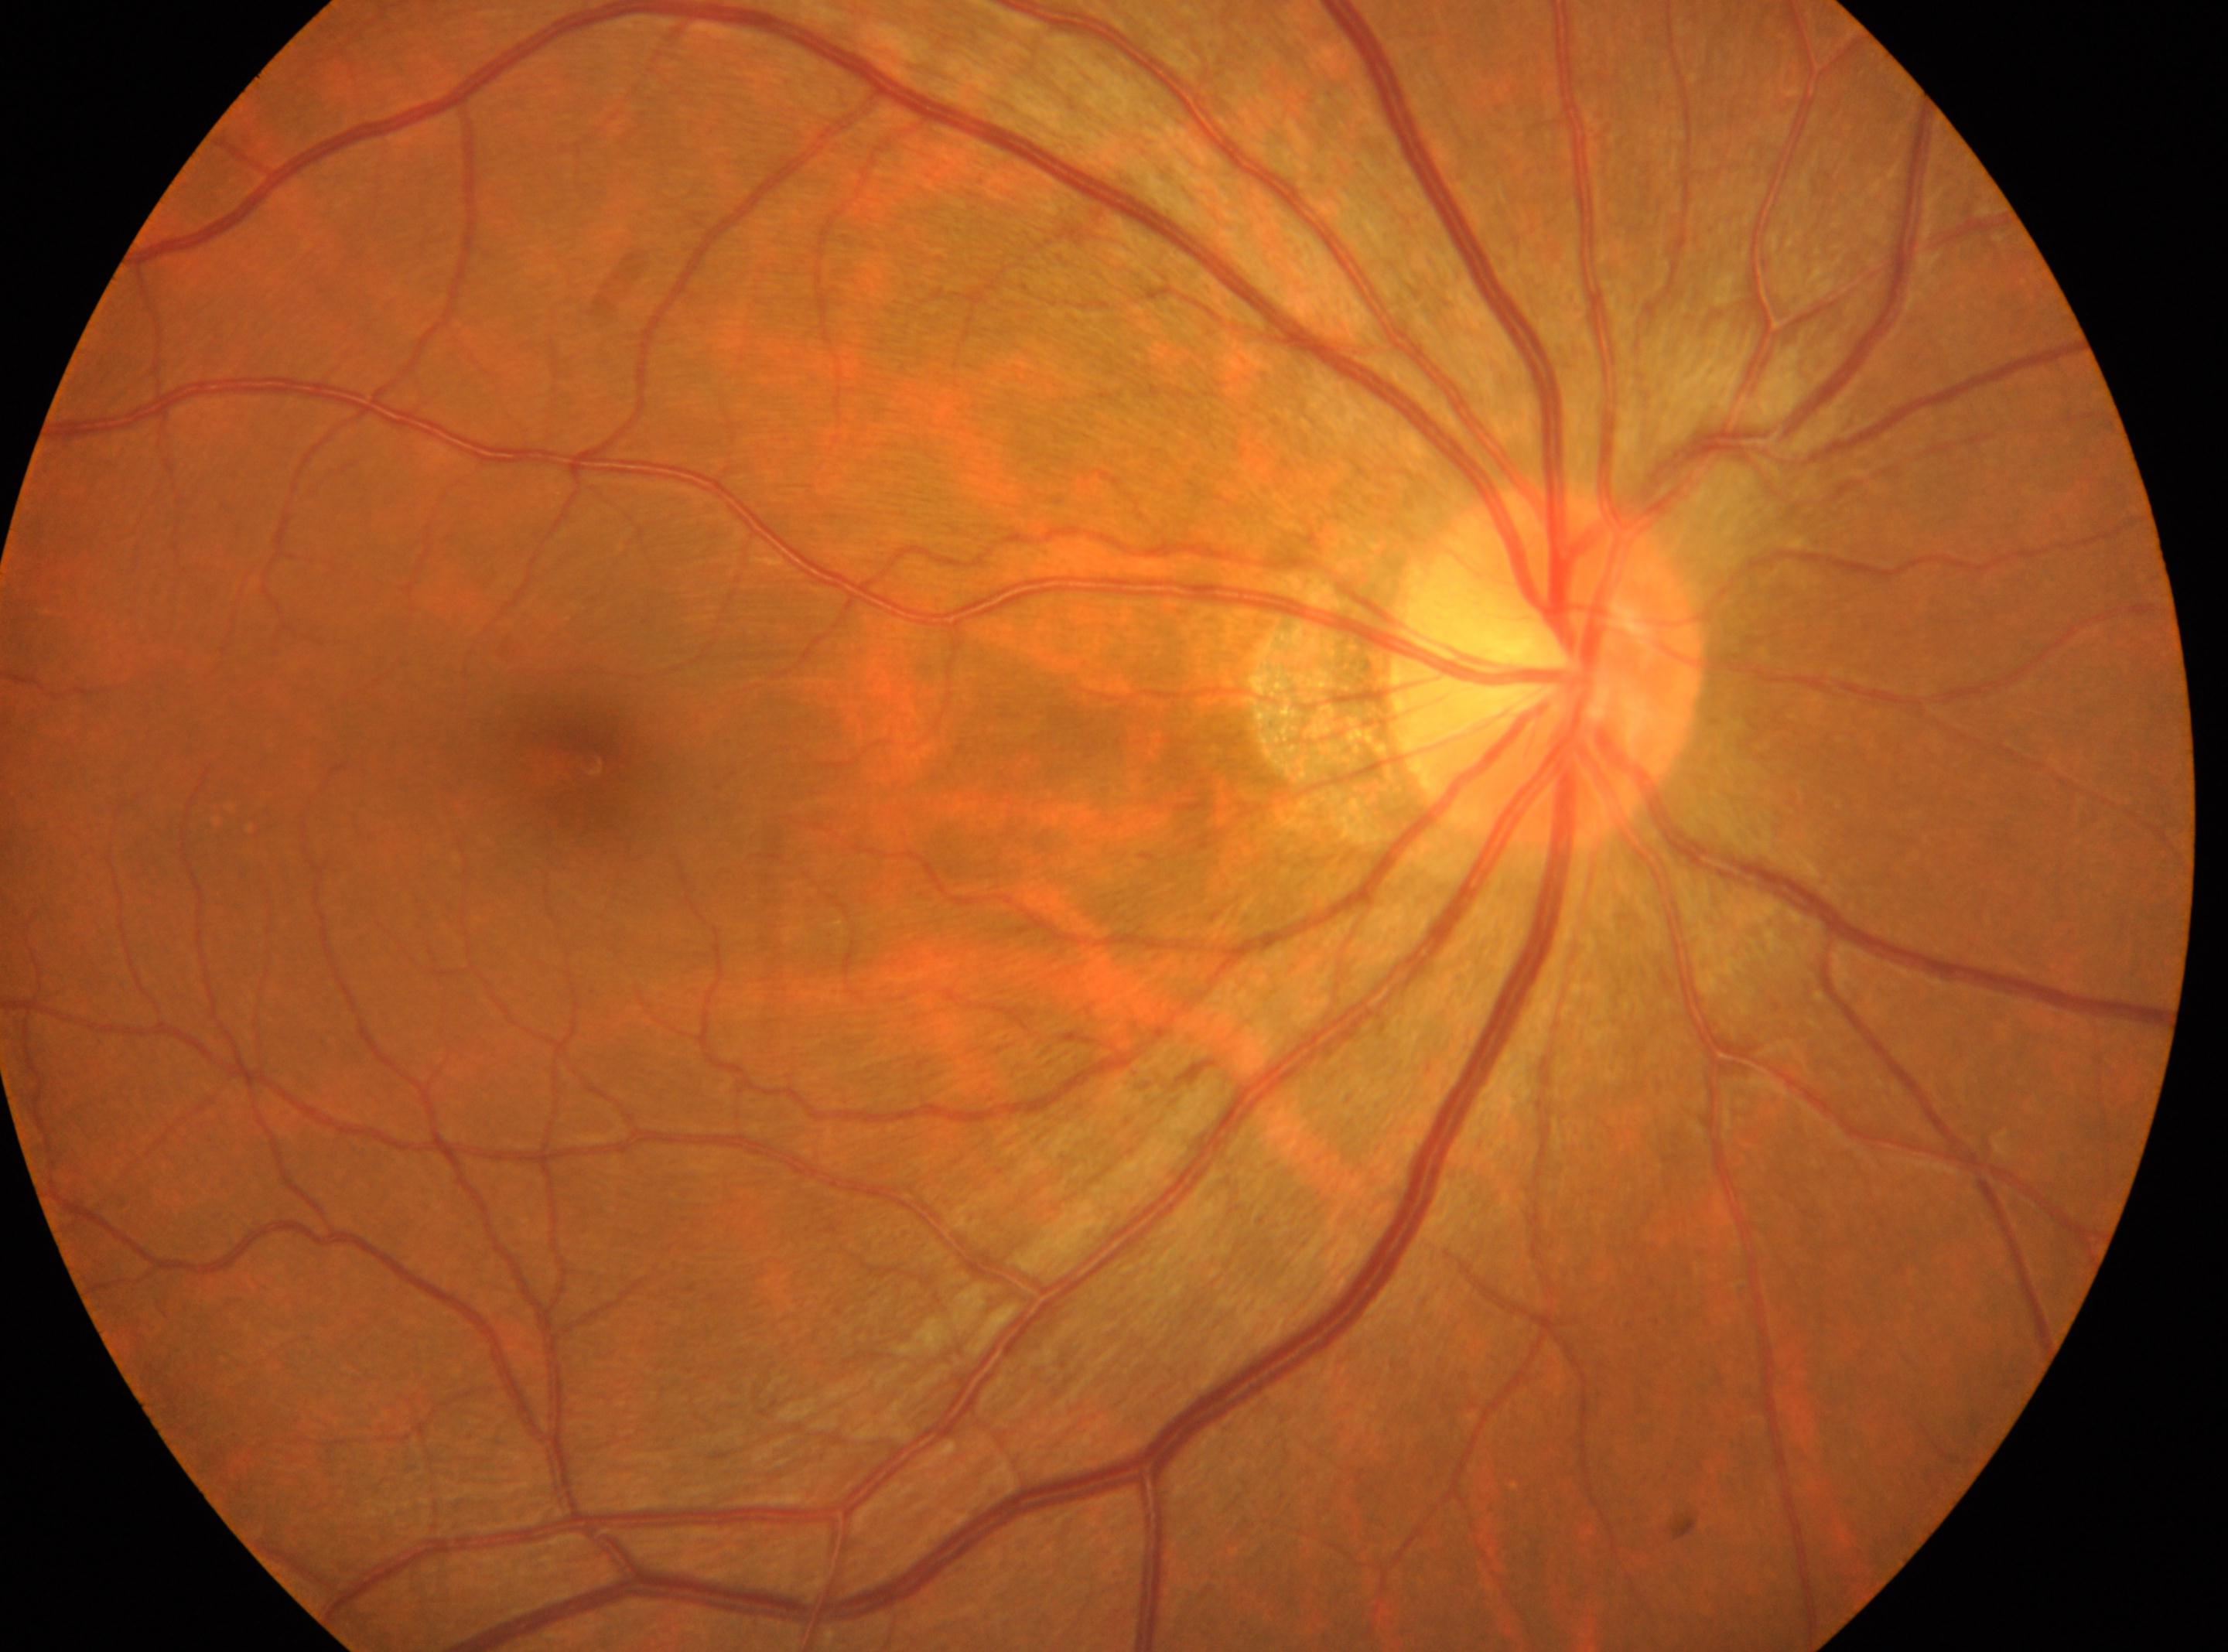

Annotations:
– optic disc: [1544, 667]
– the fovea: [589, 761]
– diabetic retinopathy severity: grade 0 (no apparent retinopathy)
– DR impression: No DR findings
– laterality: the right eye